Color fundus image, 1659x2212px, captured on a Remidio smartphone fundus camera.
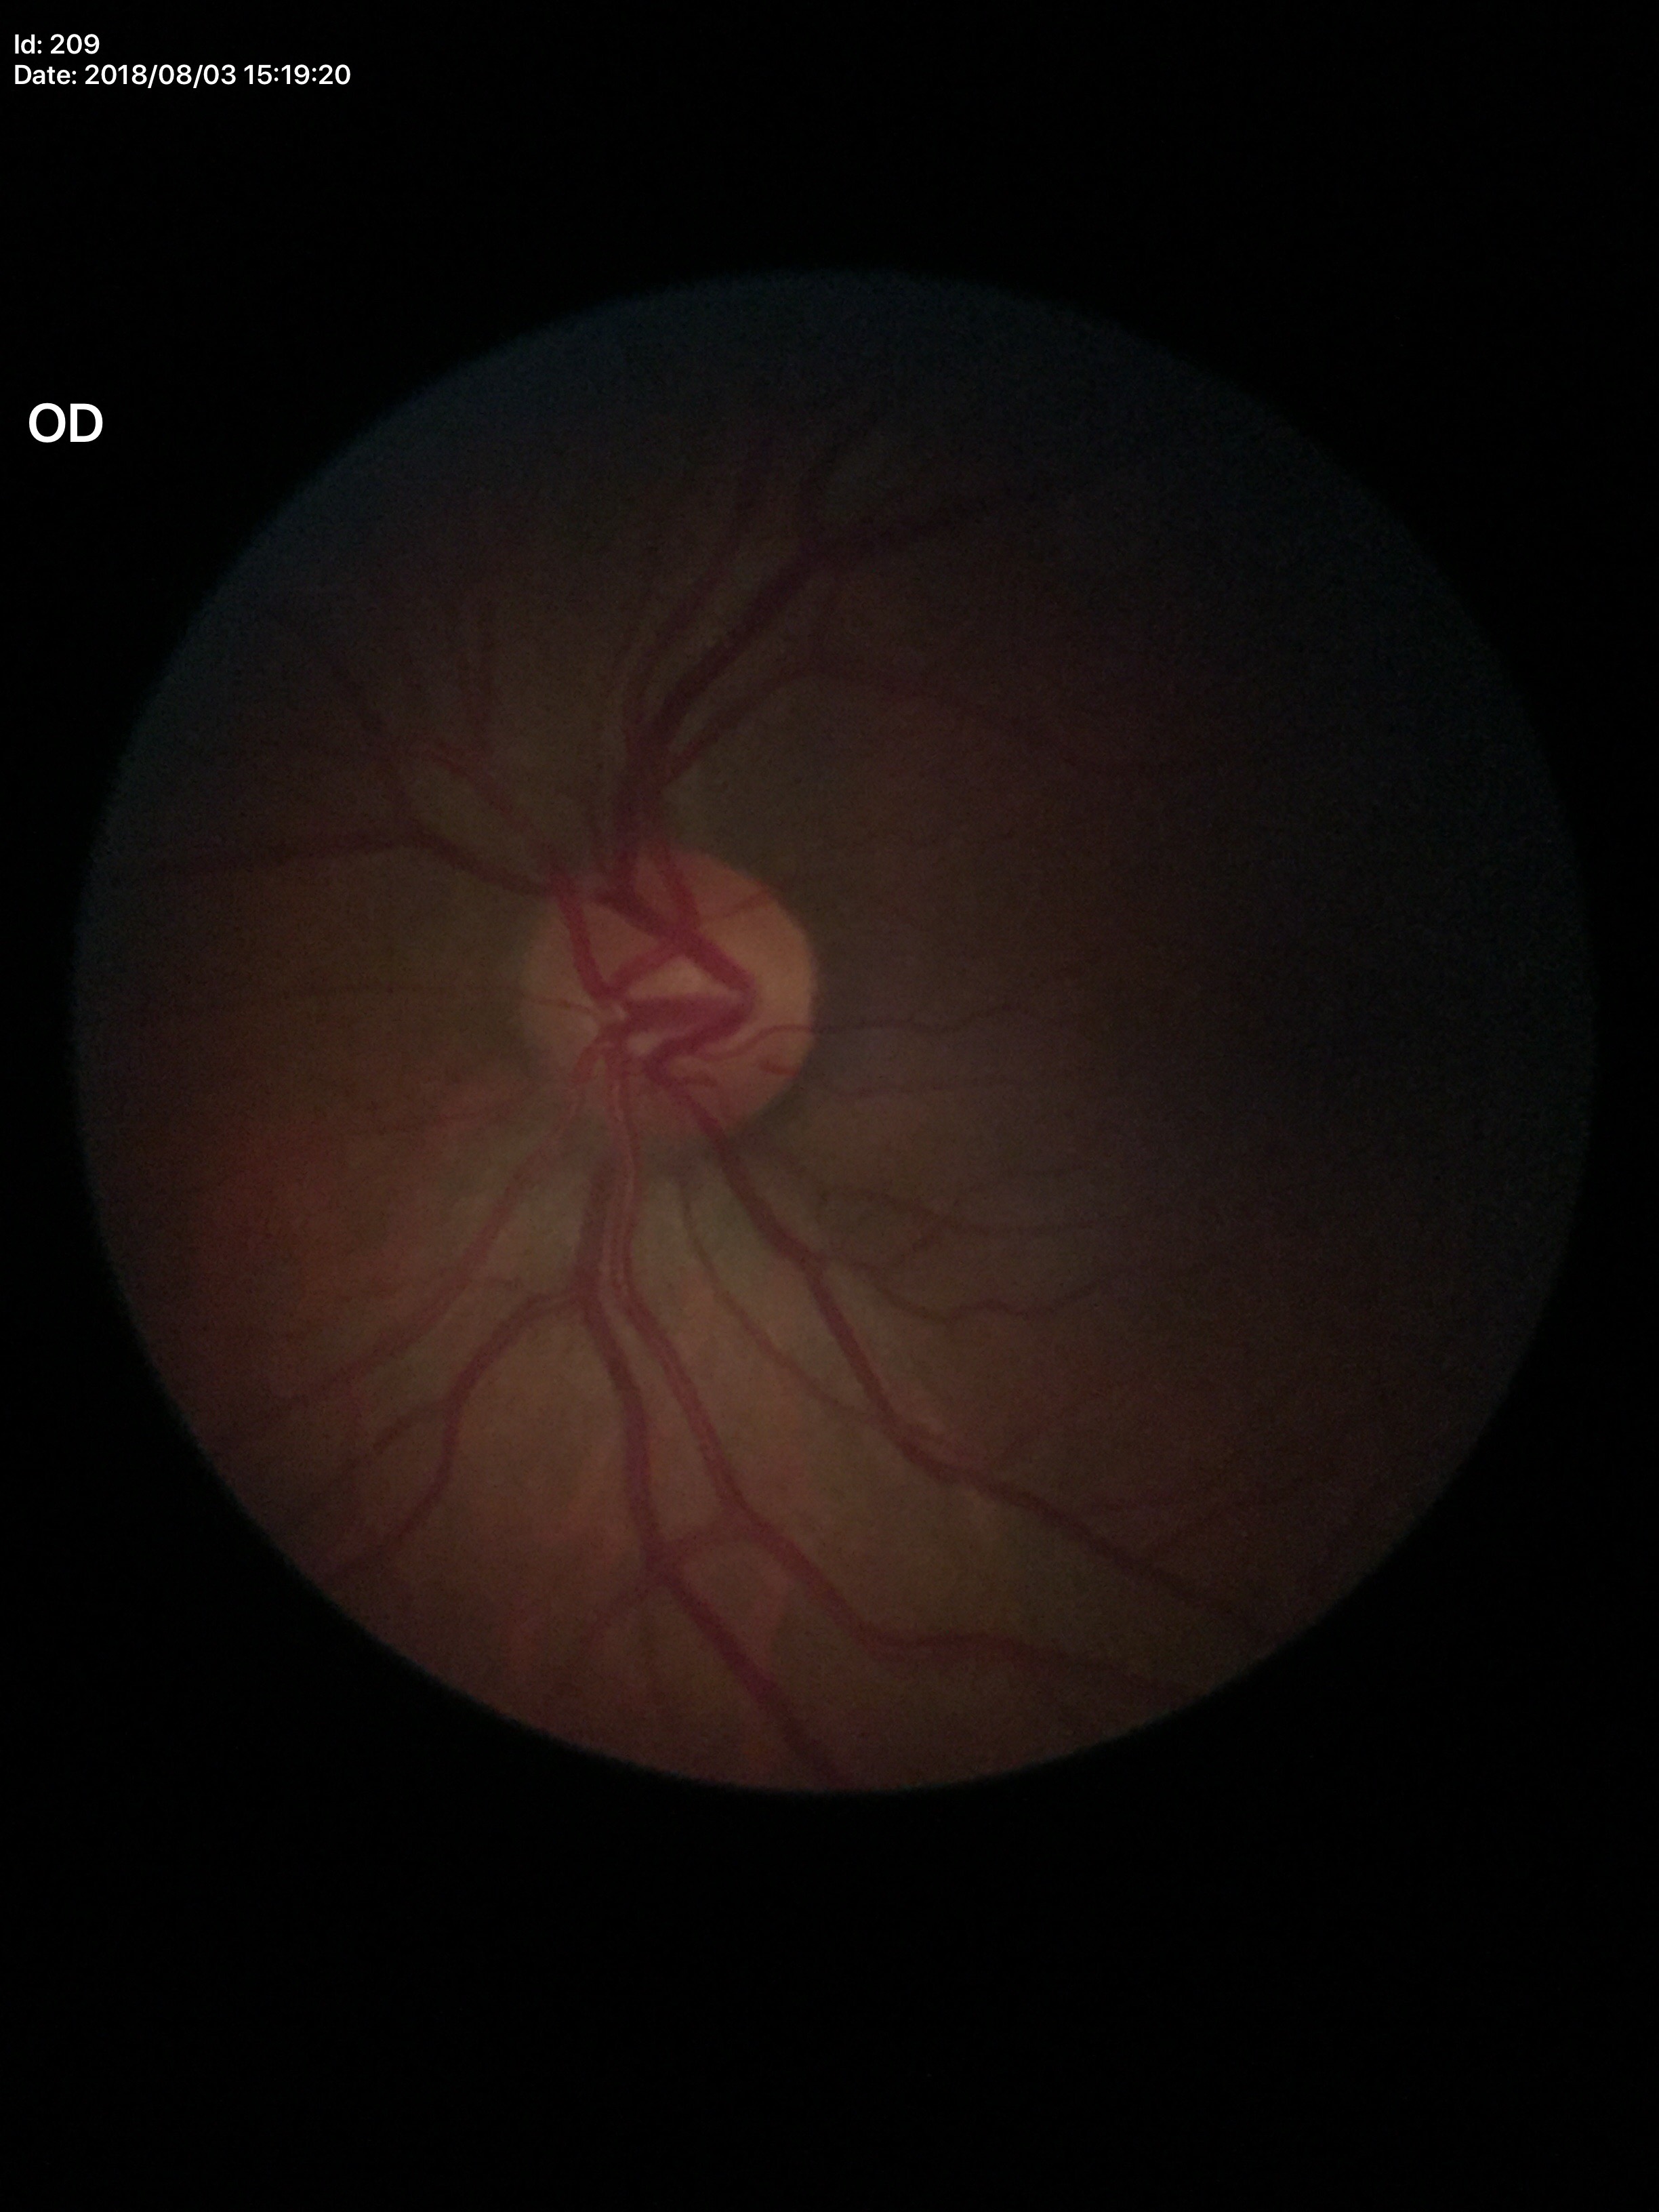

No glaucomatous findings (5/5 ophthalmologists in agreement).
Horizontal cup-disc ratio (HCDR): 0.60.
Vertical CDR (VCDR): 0.48.
Area cup-disc ratio (ACDR) of 0.30.